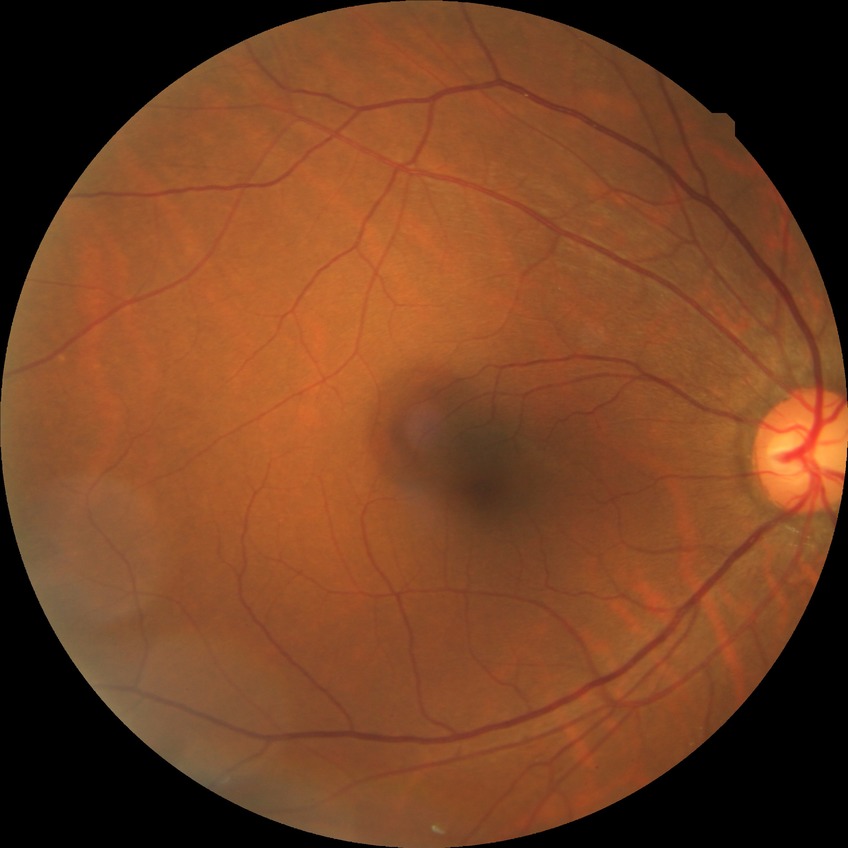

Davis stage is NDR.